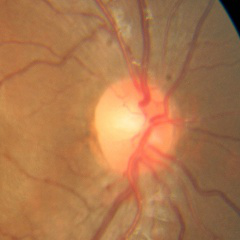 Color fundus photograph showing no glaucoma.